Color fundus image. 848x848. Camera: NIDEK AFC-230: 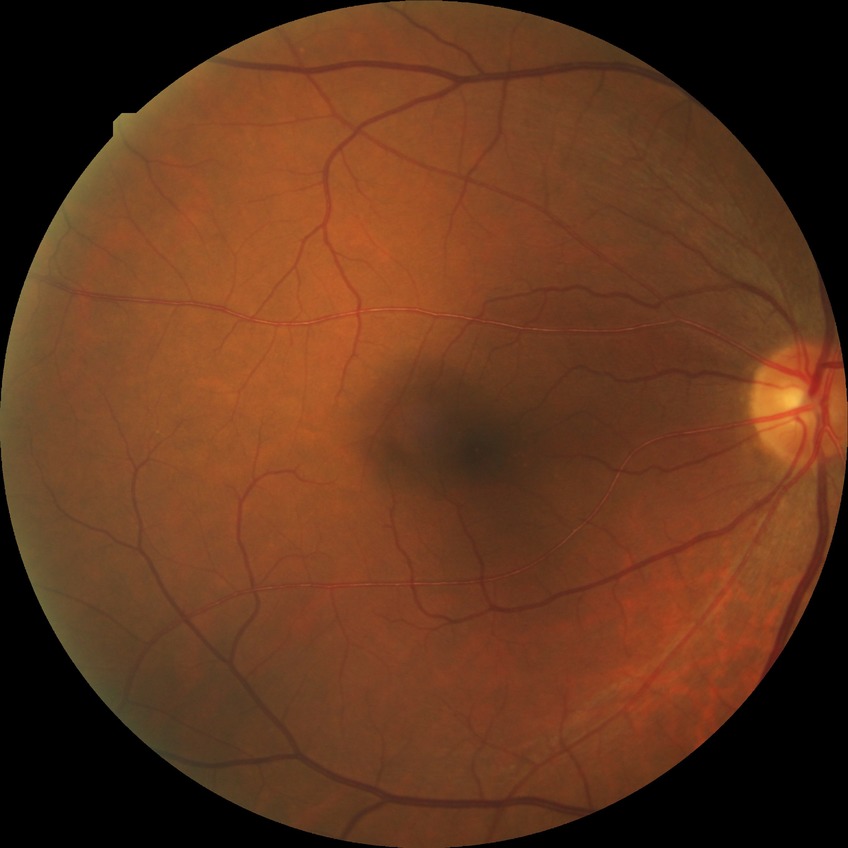
Diabetic retinopathy (DR) is simple diabetic retinopathy (SDR).